Pediatric wide-field fundus photograph: 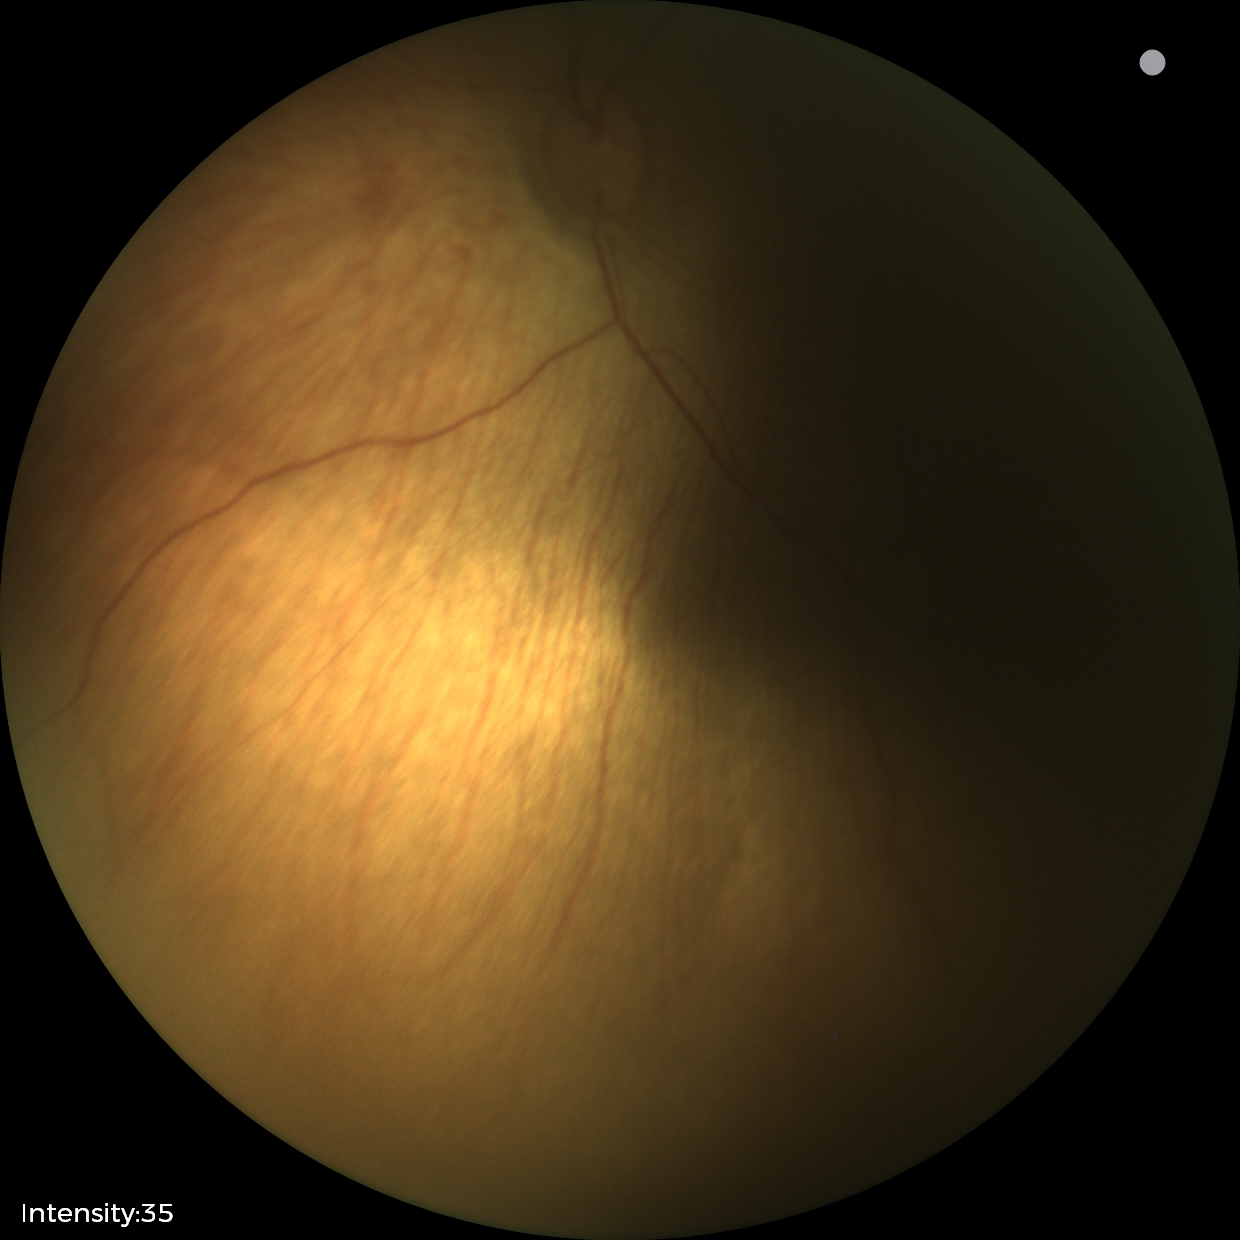 Series diagnosed as status post retinopathy of prematurity (ROP).
No plus disease.